Camera: NIDEK AFC-230; FOV: 45 degrees; without pupil dilation — 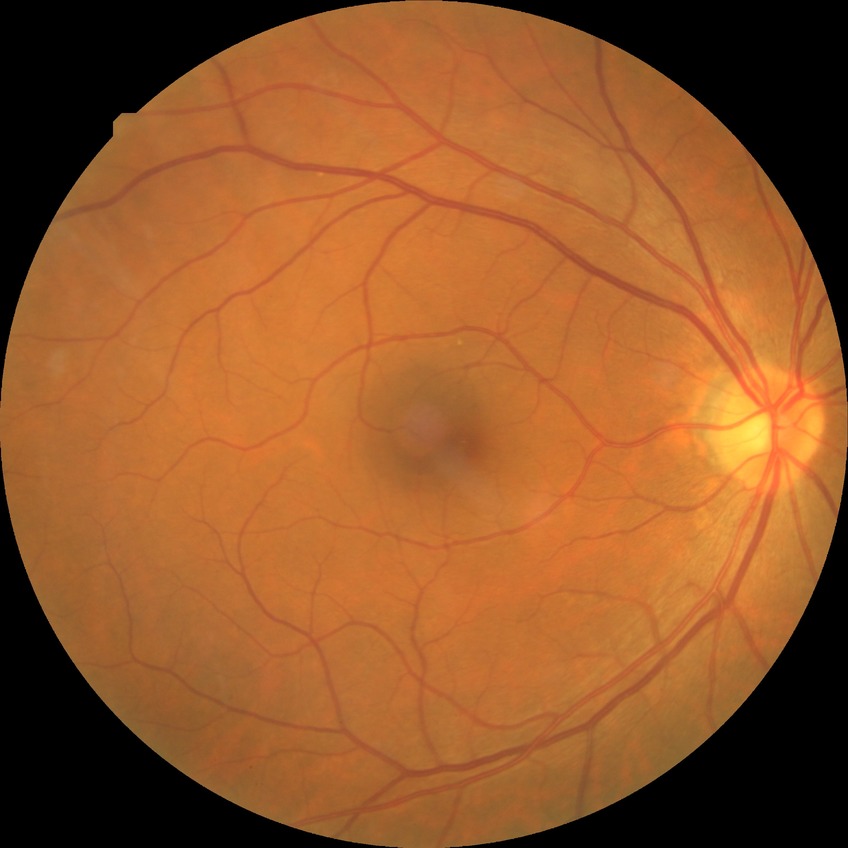 diabetic retinopathy (DR): no diabetic retinopathy (NDR).